45° field of view — 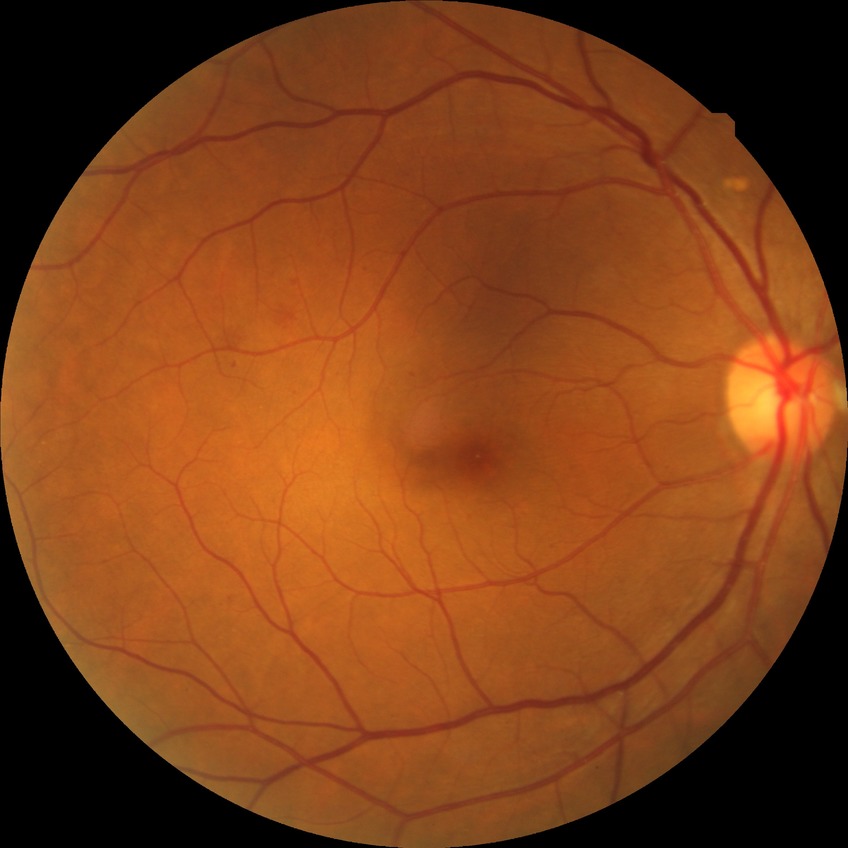
Davis grade: SDR.